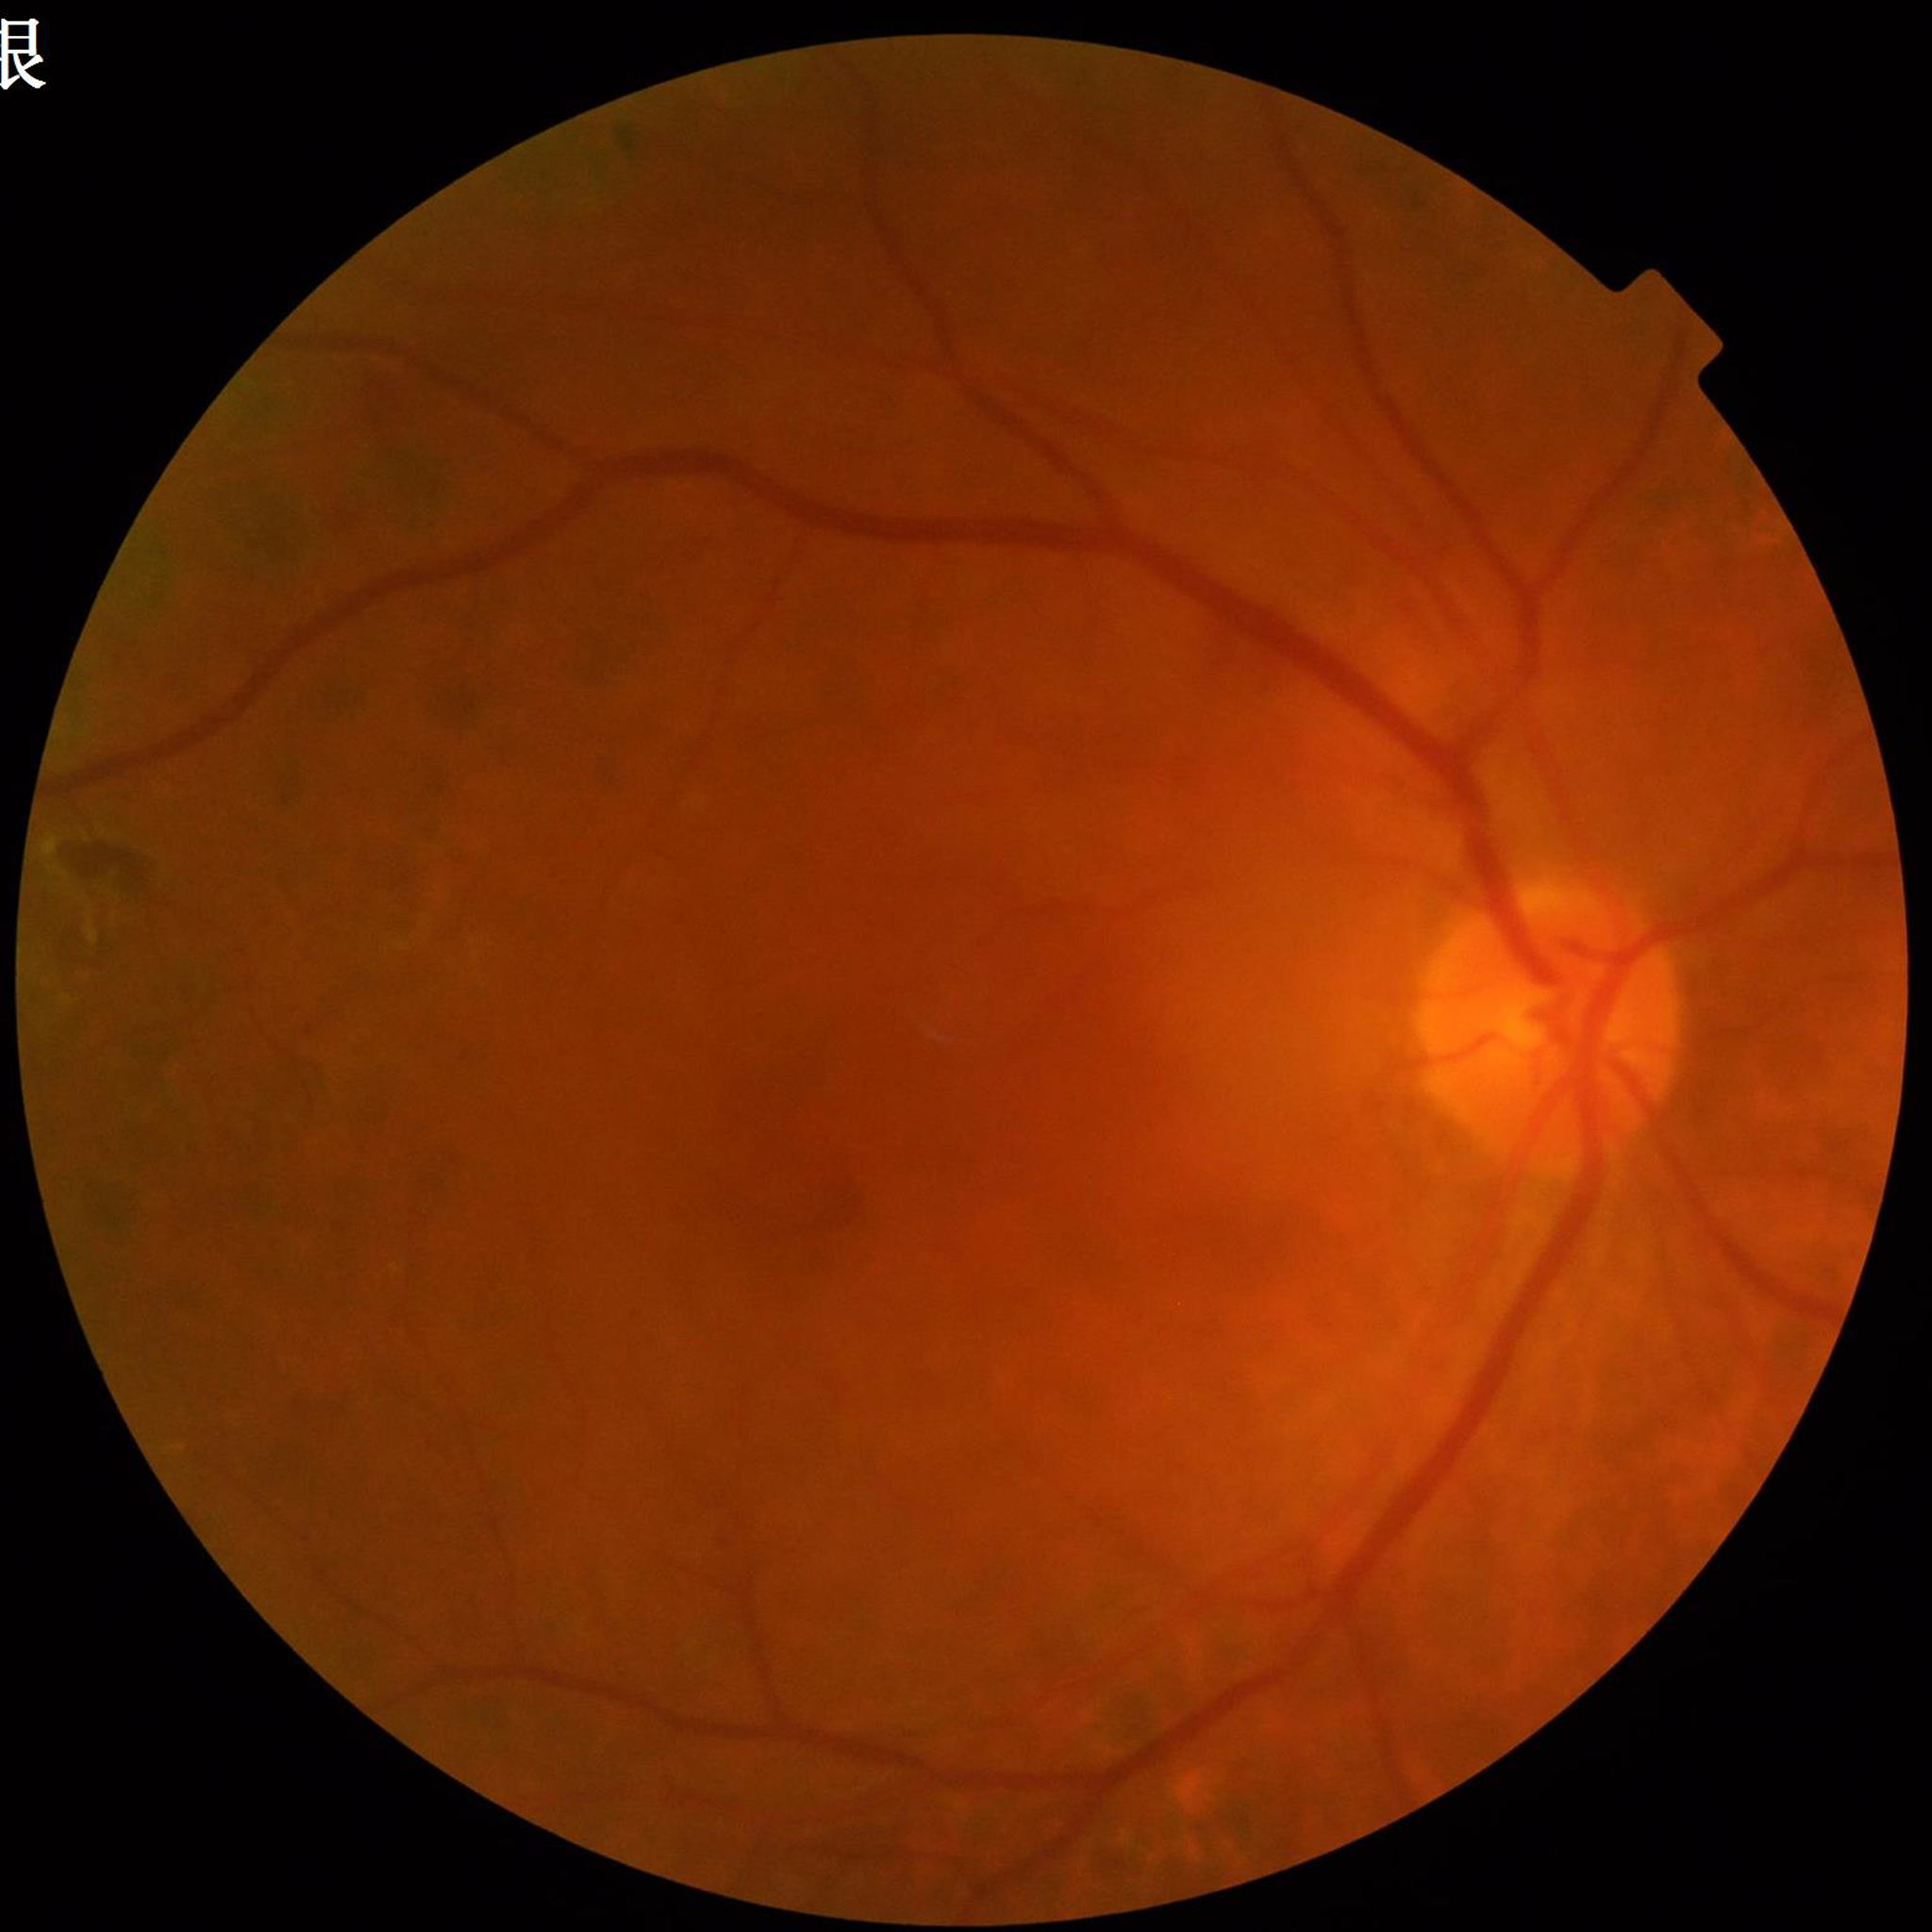
Automated quality assessment: adequate; Disease class: diabetic retinopathy.